Infant wide-field retinal image; 1440x1080px; camera: Natus RetCam Envision (130° FOV):
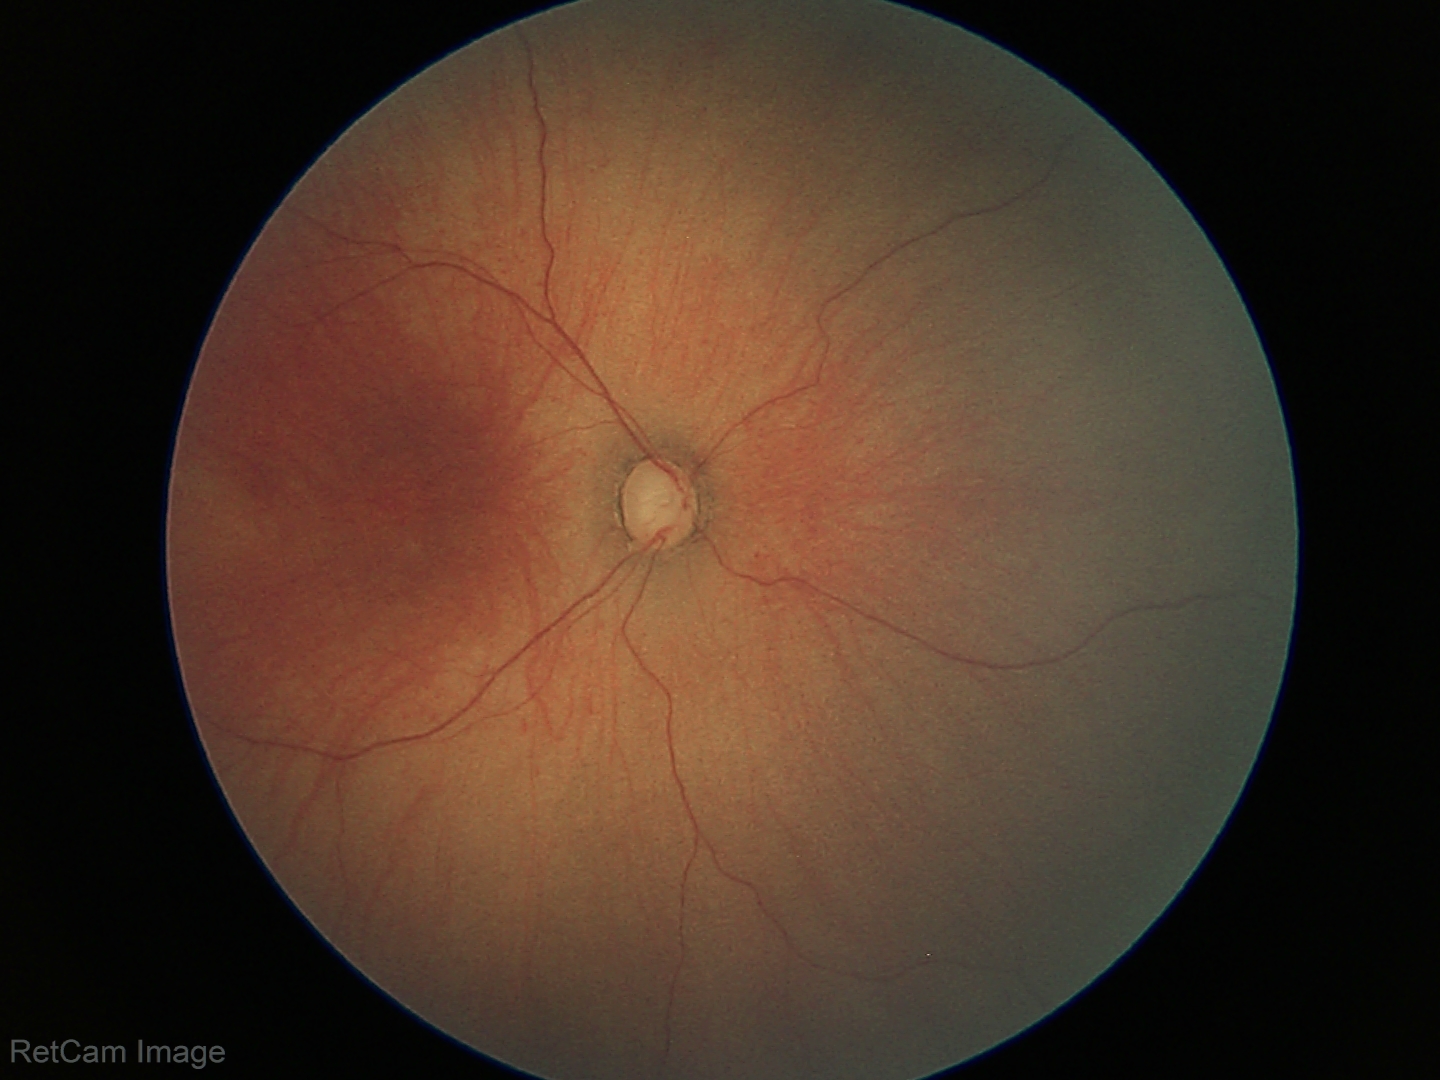 From an examination with diagnosis of retinopathy of prematurity stage 1.
No plus disease.